1932x1932.
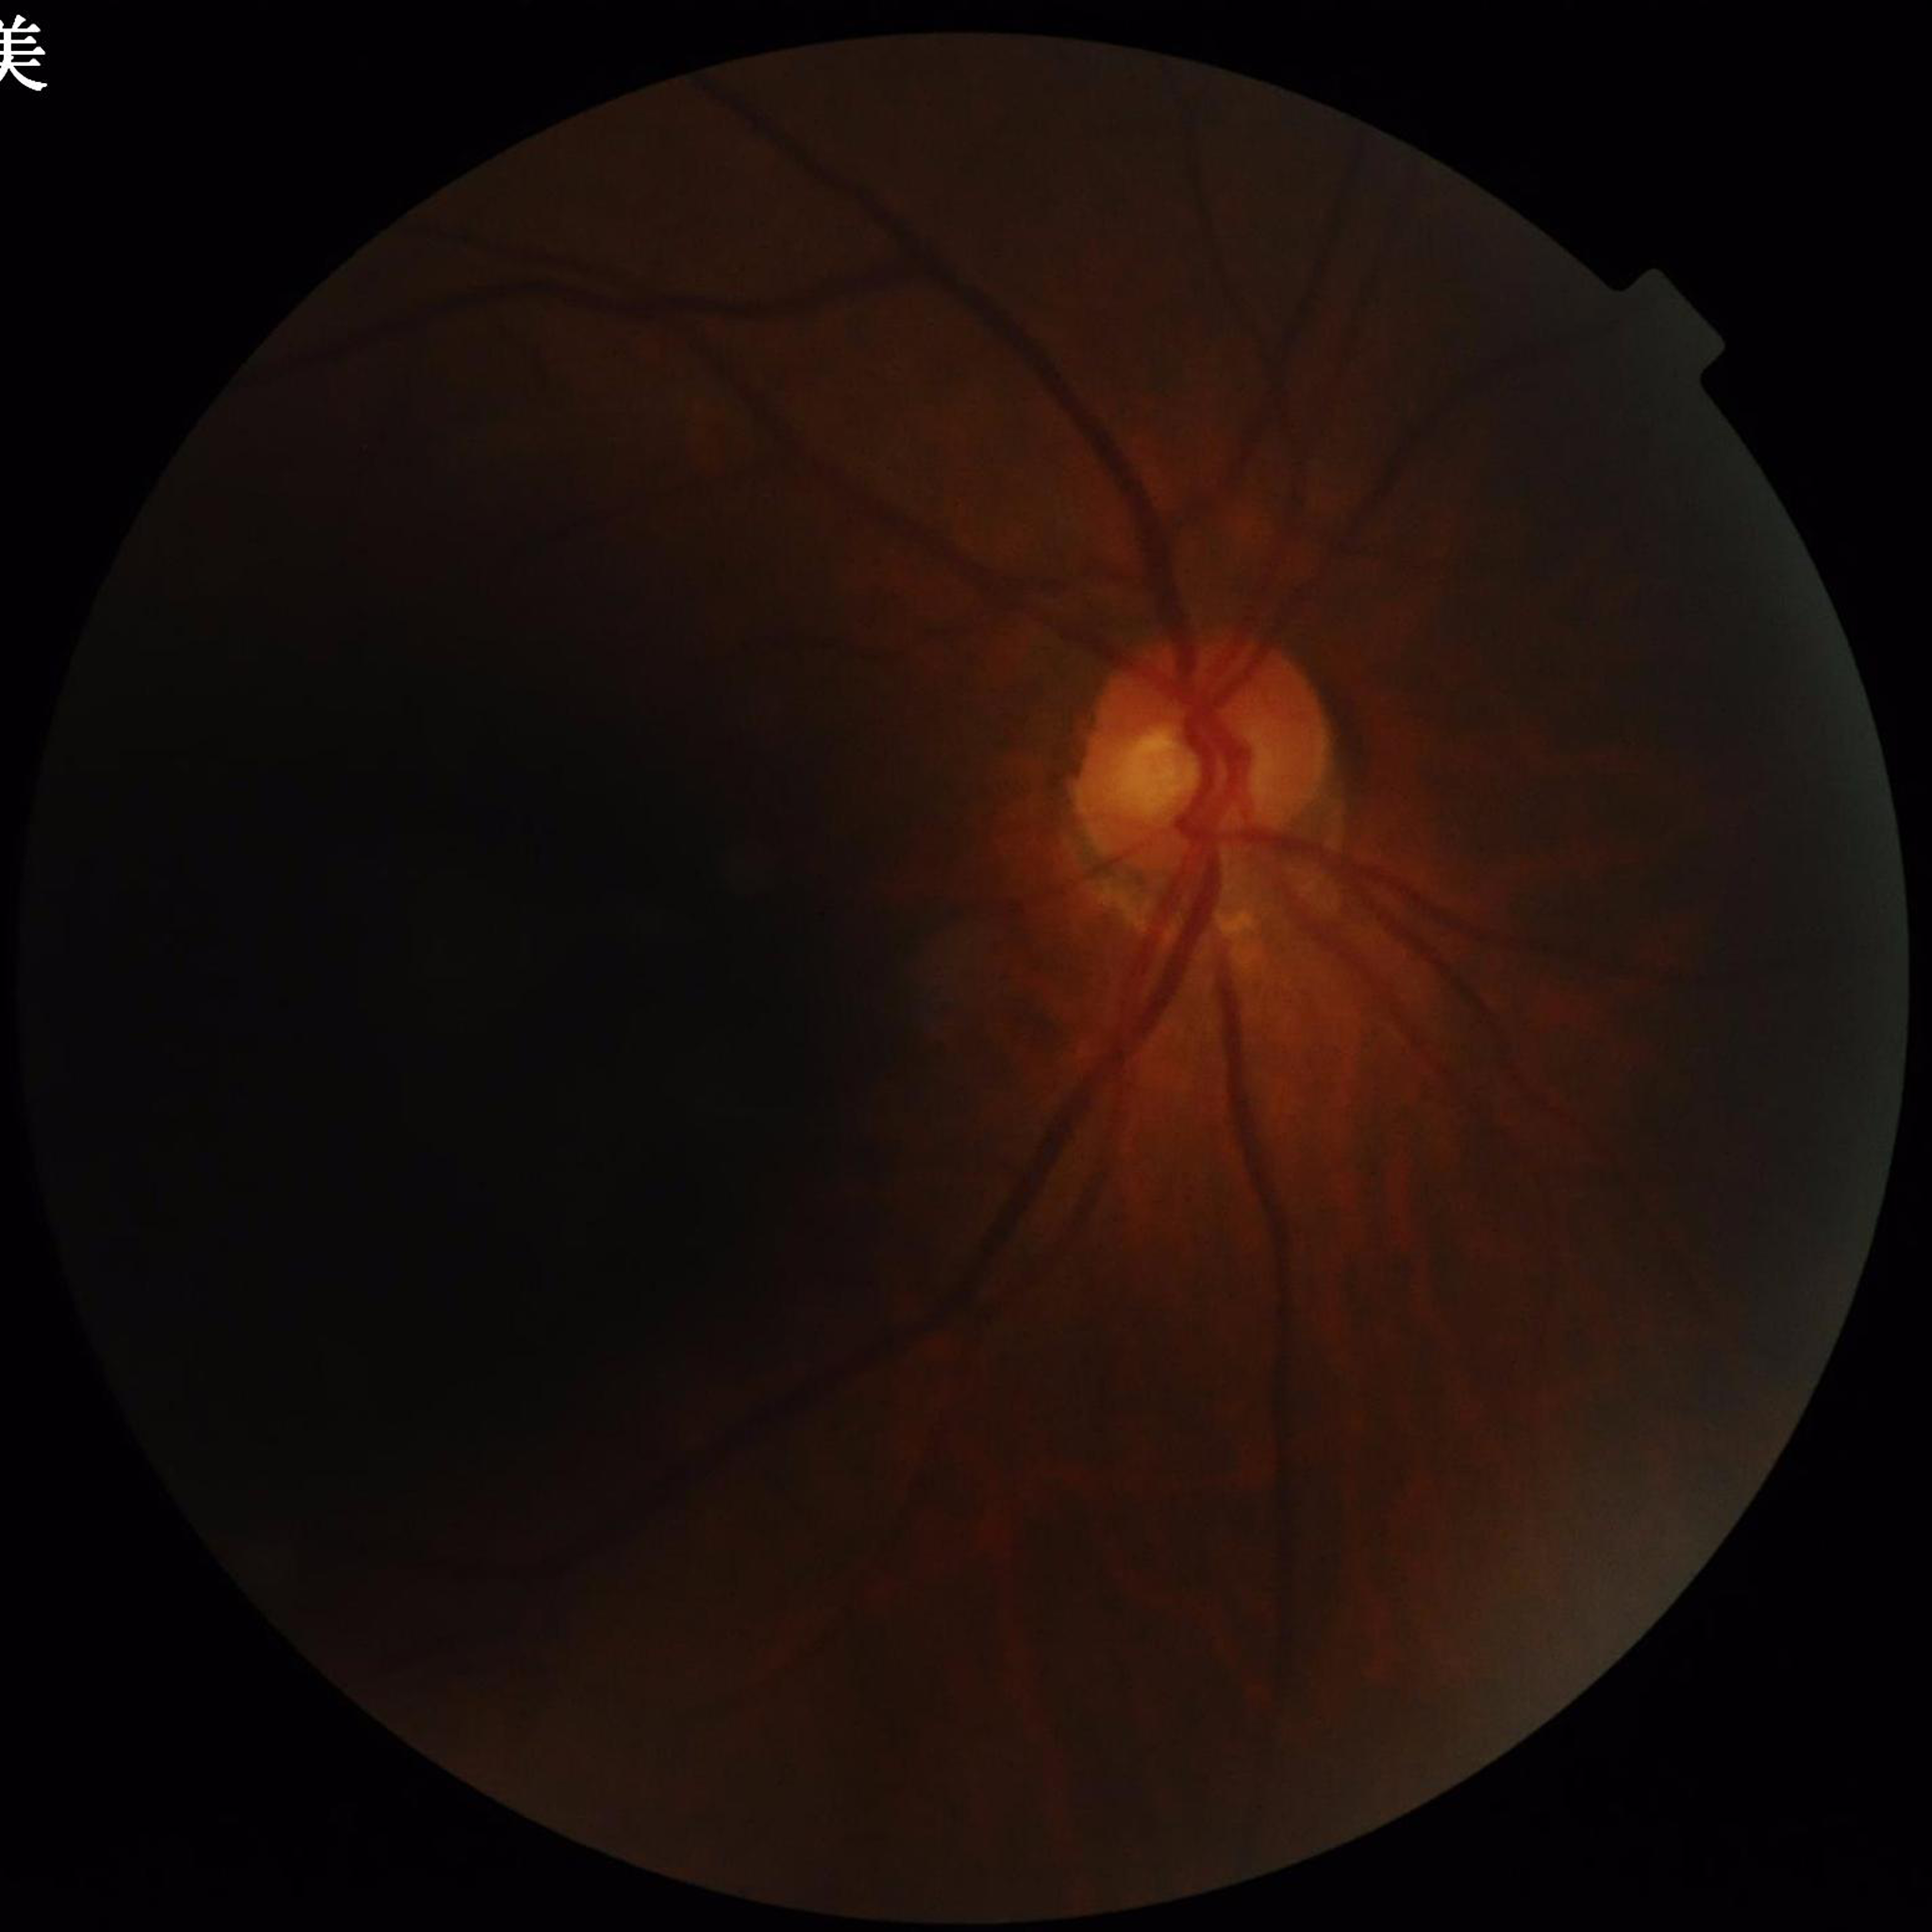   image_quality: poor — illumination/color distortion, blur
  diagnosis: glaucoma